Color fundus photograph; 1932x1932; 45° FOV.
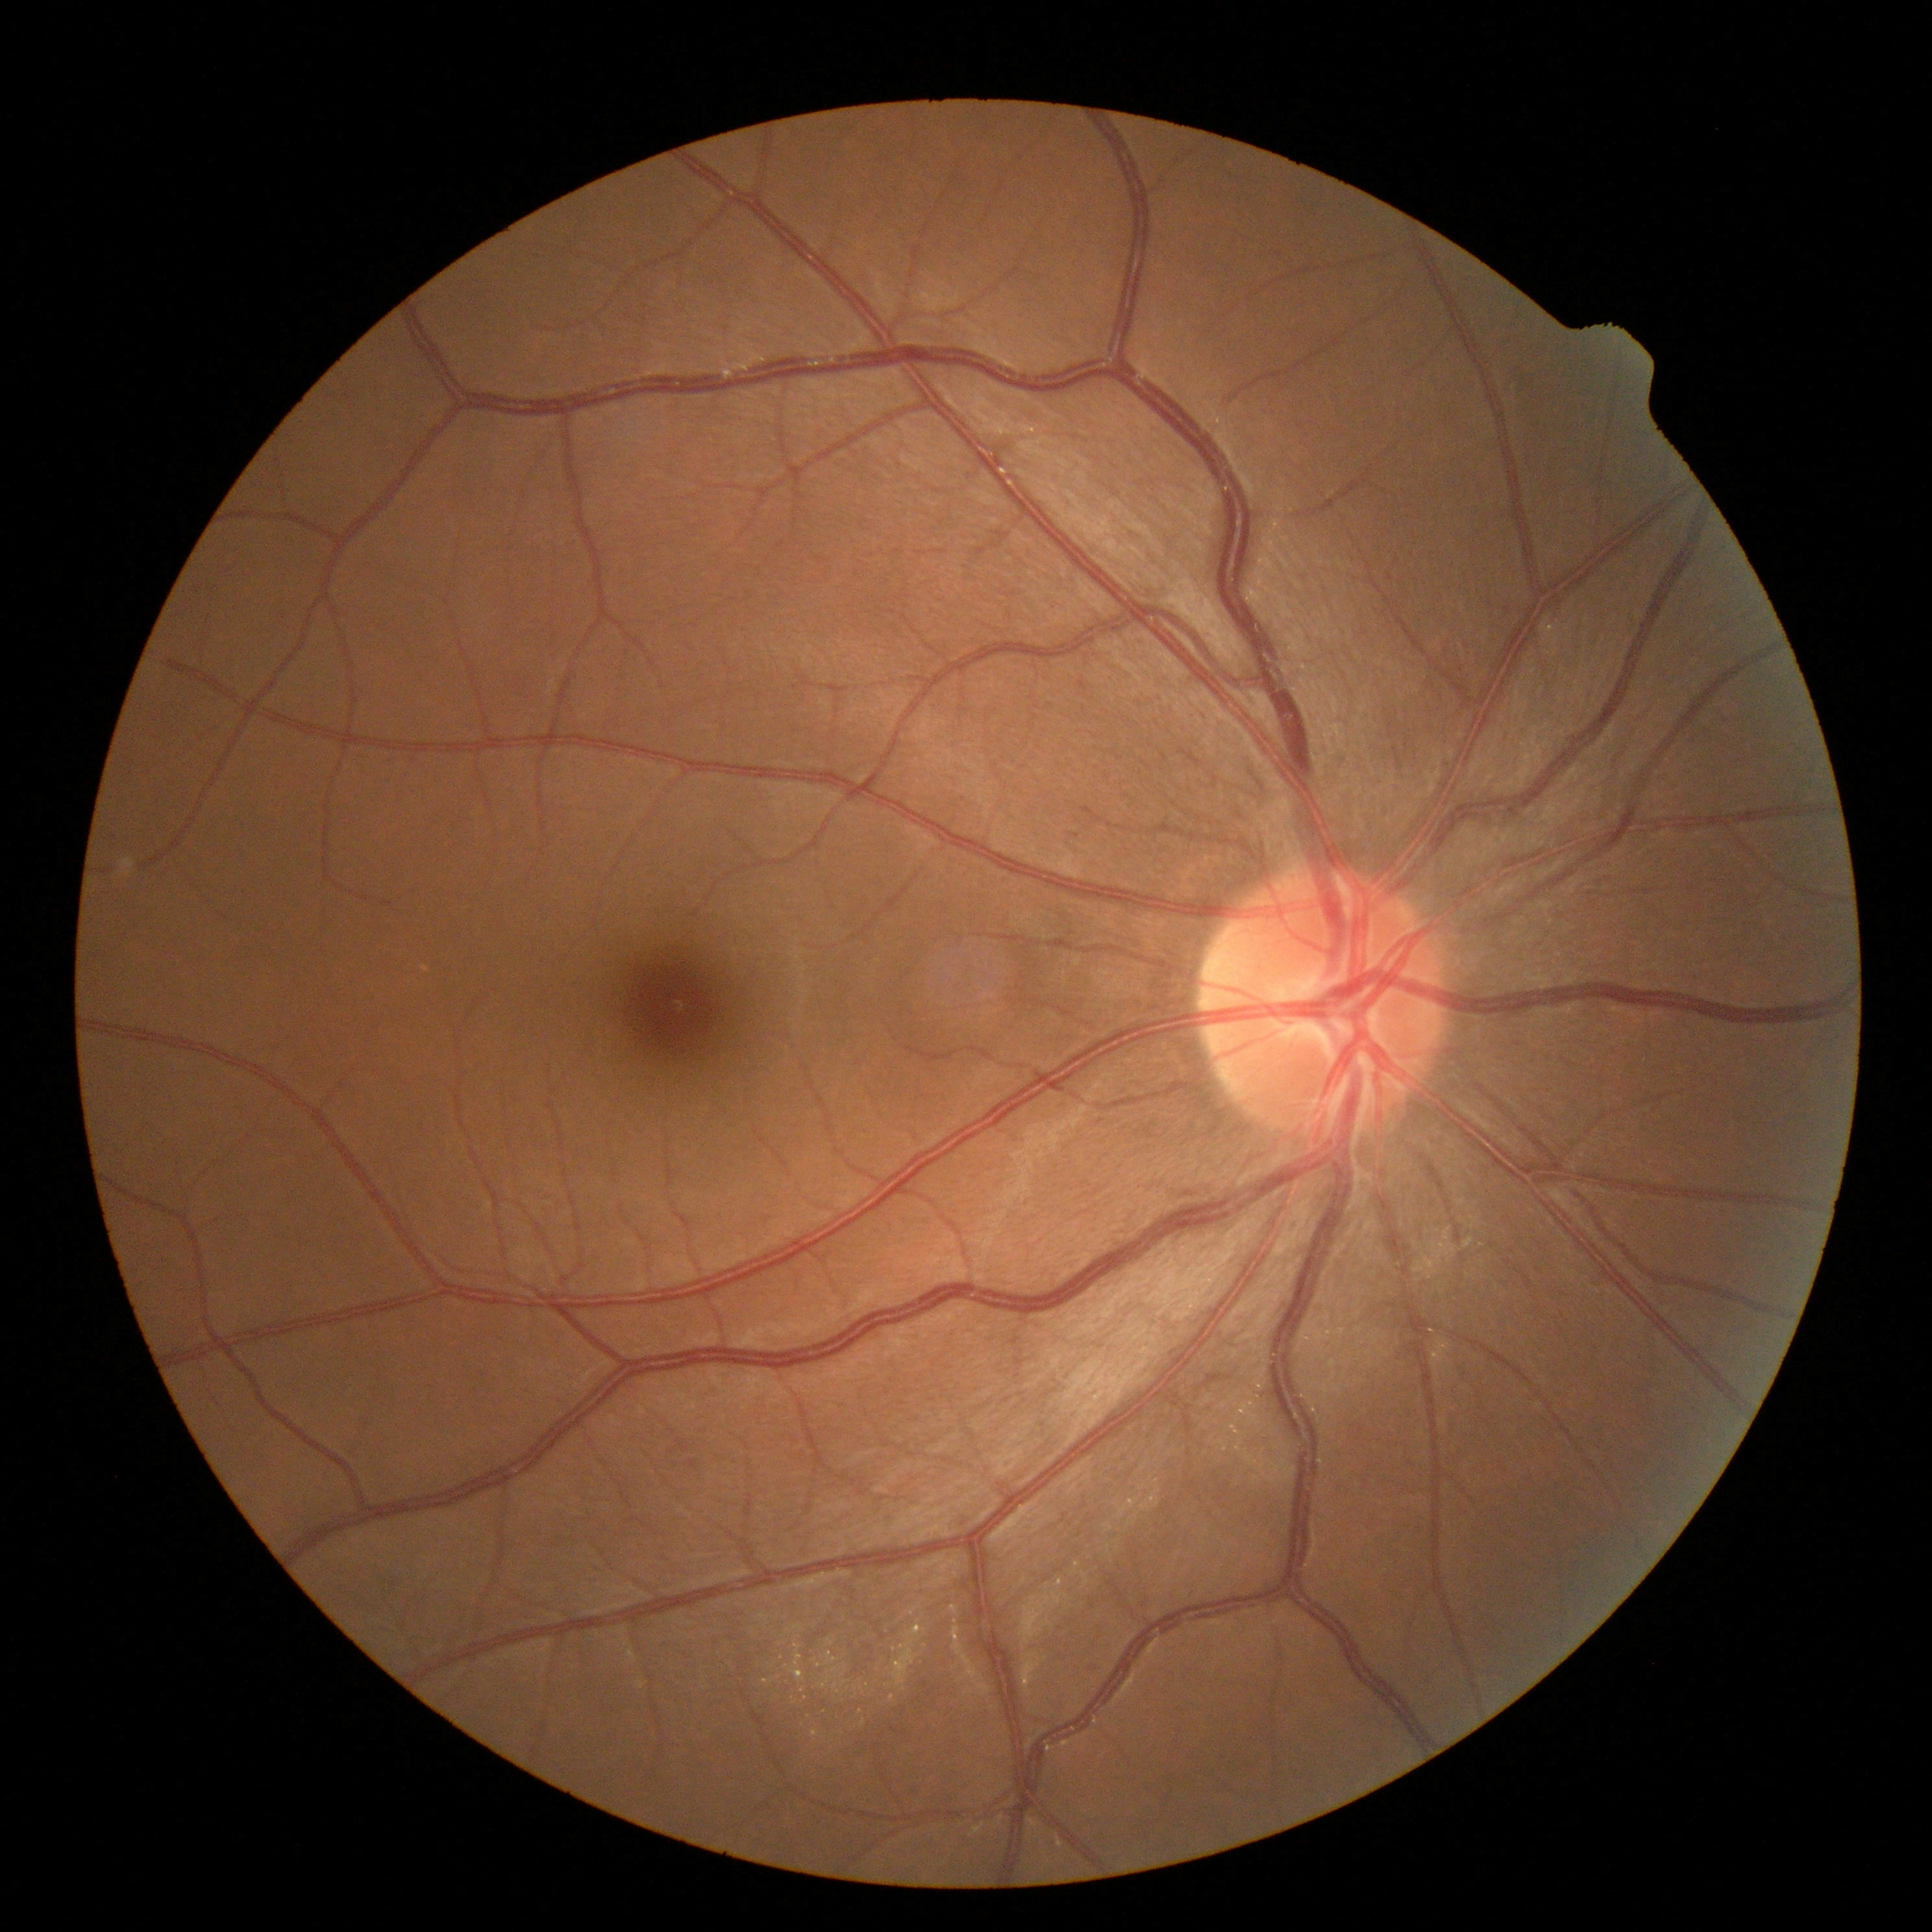

DR grade=0/4.